Wide-field fundus photograph of an infant
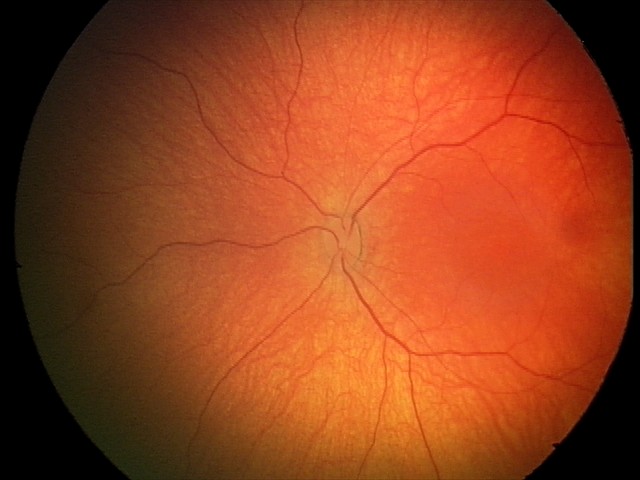 No retinal pathology identified on screening.